Davis DR grading:
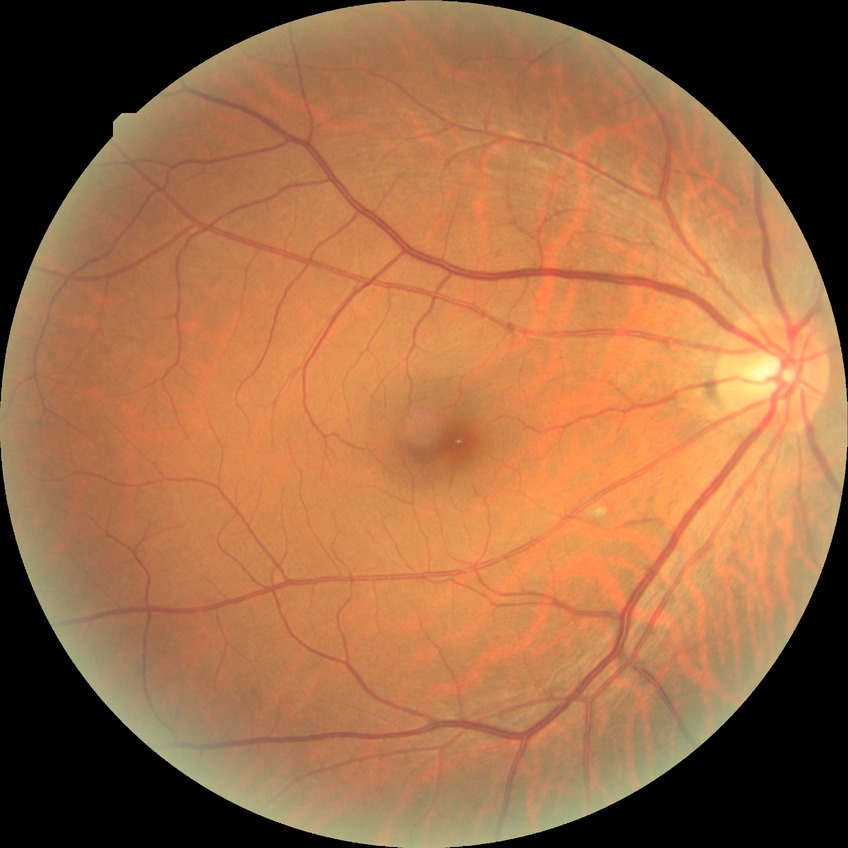
DR impression@no signs of DR, DR@NDR.